Retinal fundus photograph; 848x848px; Davis DR grading; NIDEK AFC-230 fundus camera; 45° FOV:
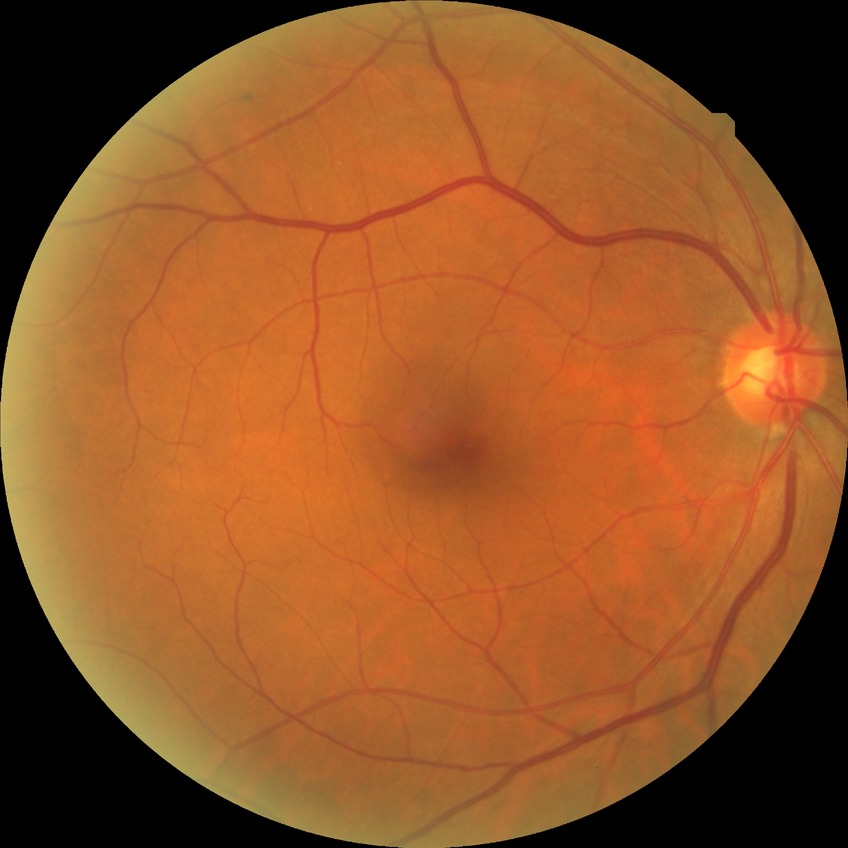

diabetic retinopathy (DR): NDR (no diabetic retinopathy).